Color fundus photograph.
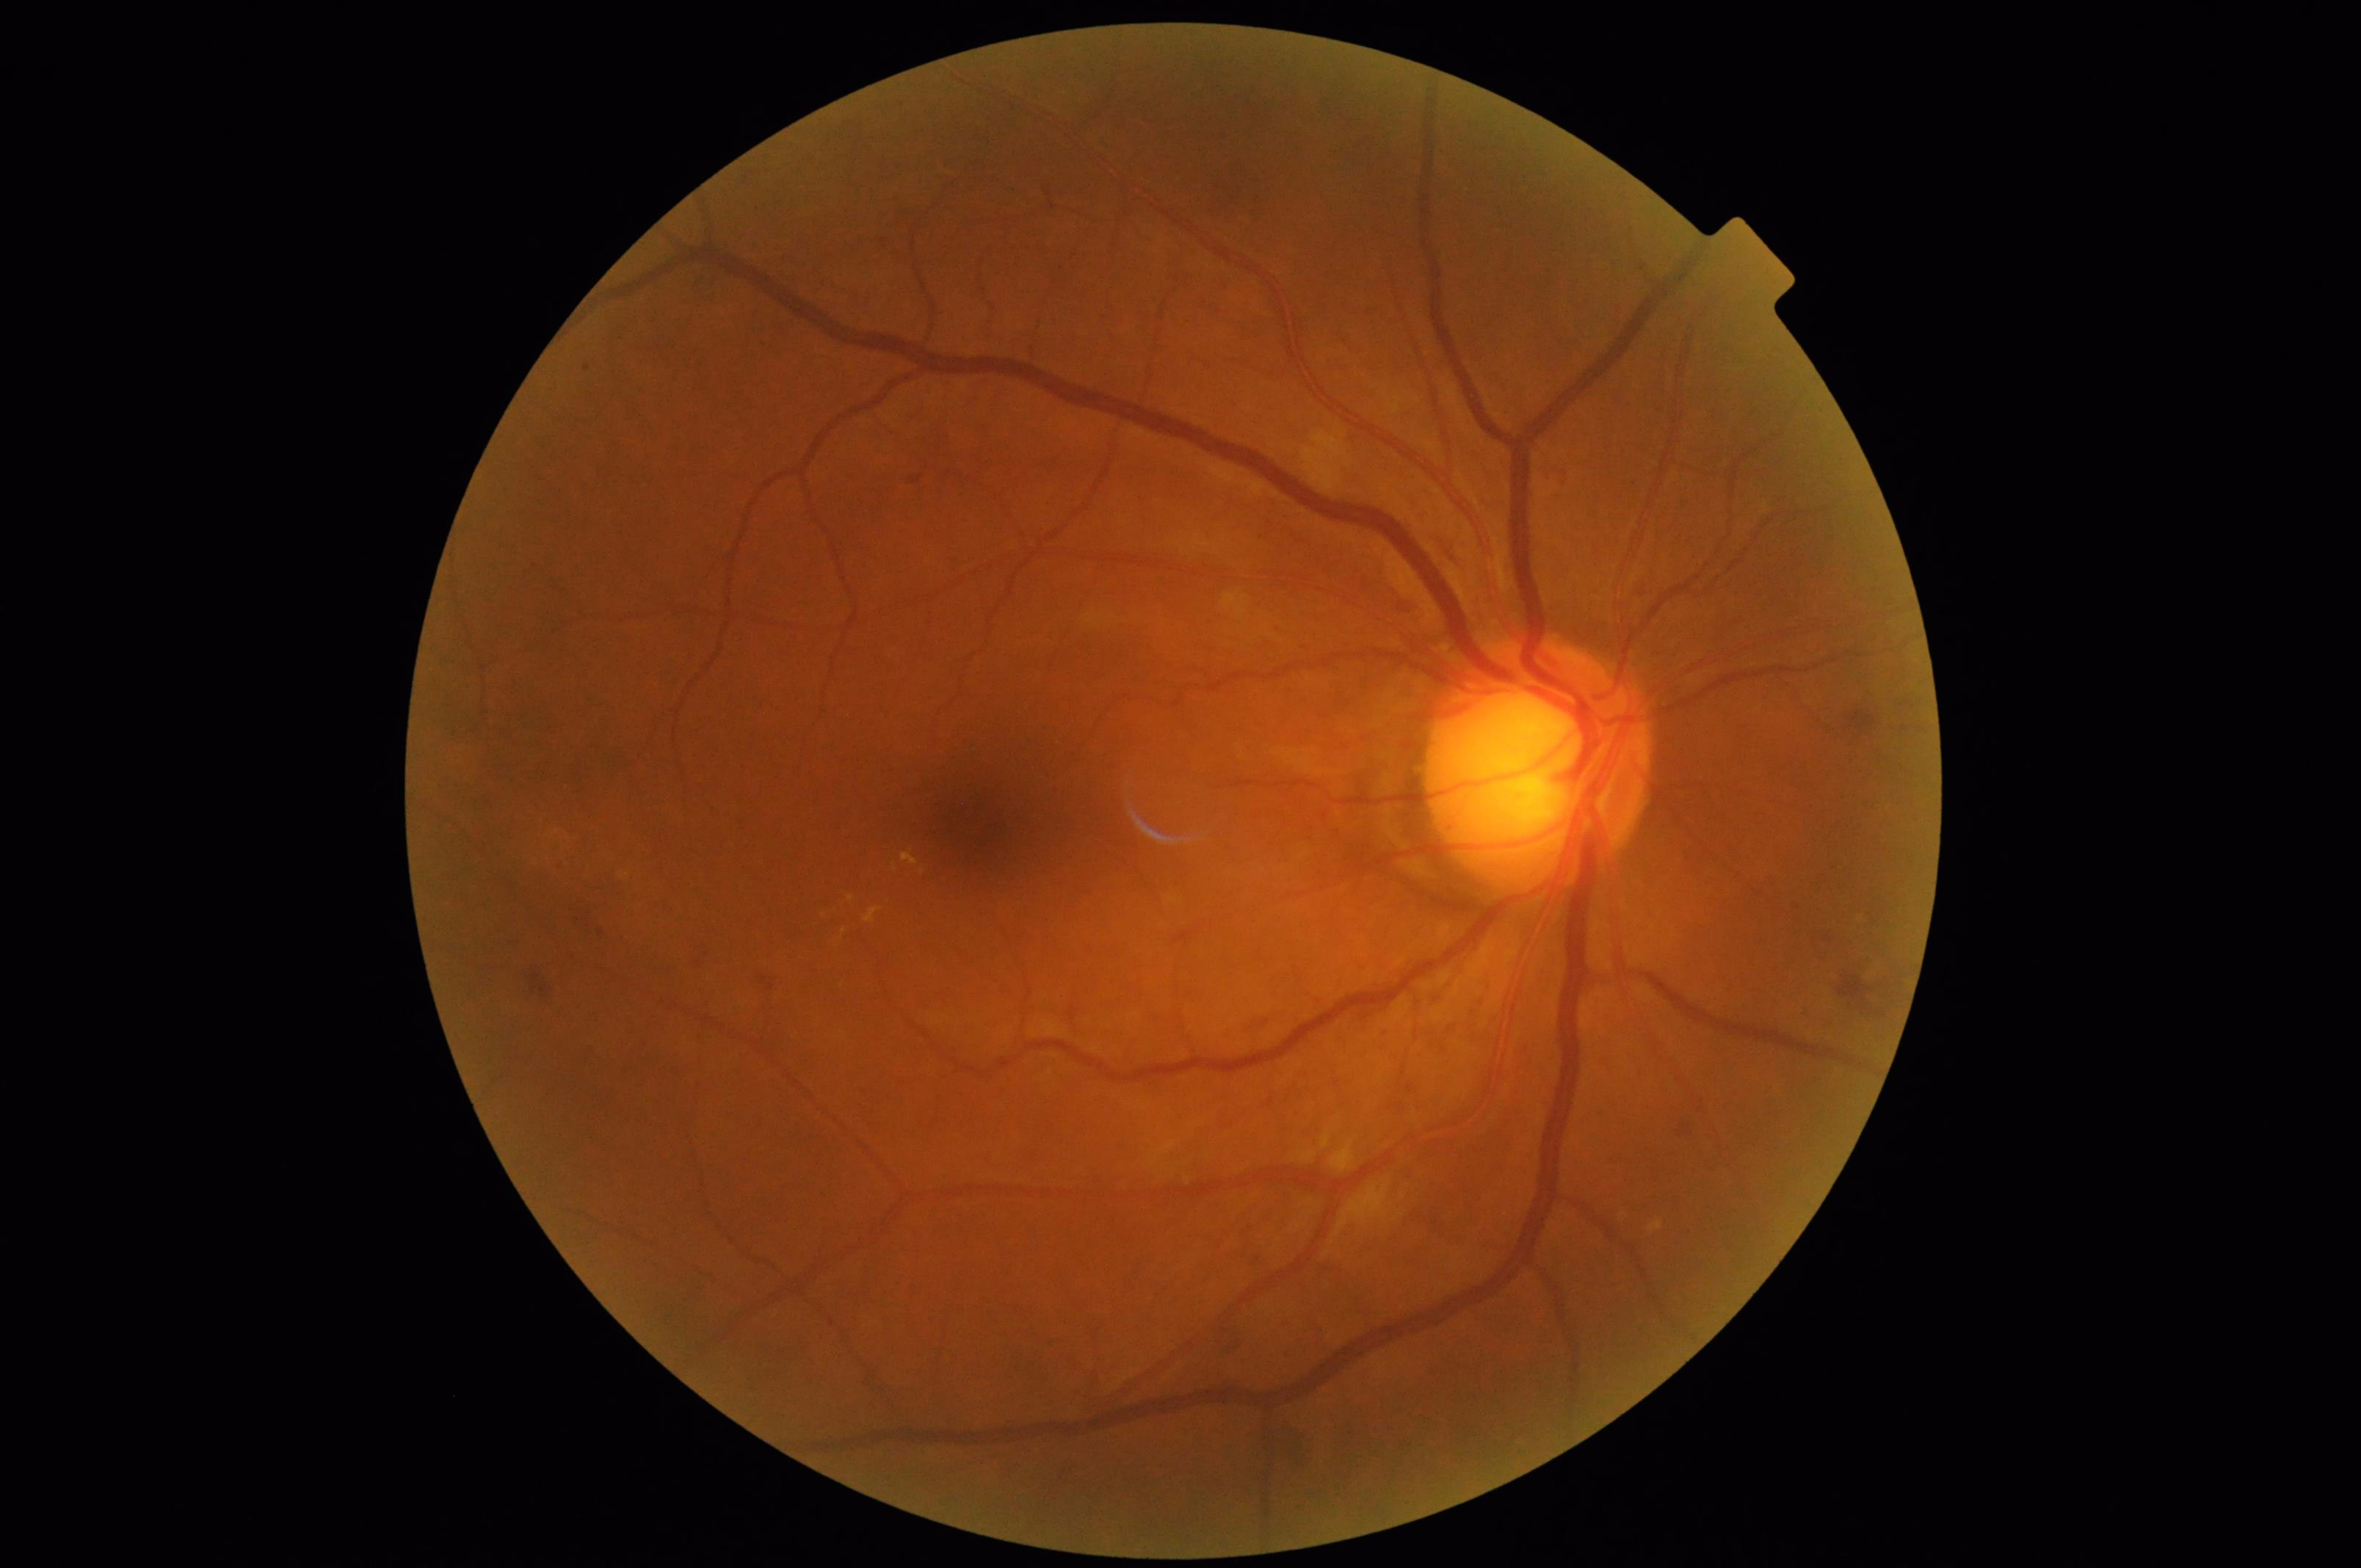

Acceptable image quality.
Image is sharp throughout the field.
Illumination is even.
Adequate contrast for distinguishing structures.